Retinal fundus photograph:
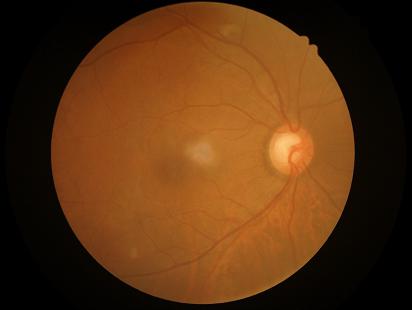 Overall quality = good and suitable for diagnostic use; Illumination/color = no over- or under-exposure; Clarity = optic disc, vessels, and background in focus; Contrast = vessels and details readily distinguishable.